CFP.
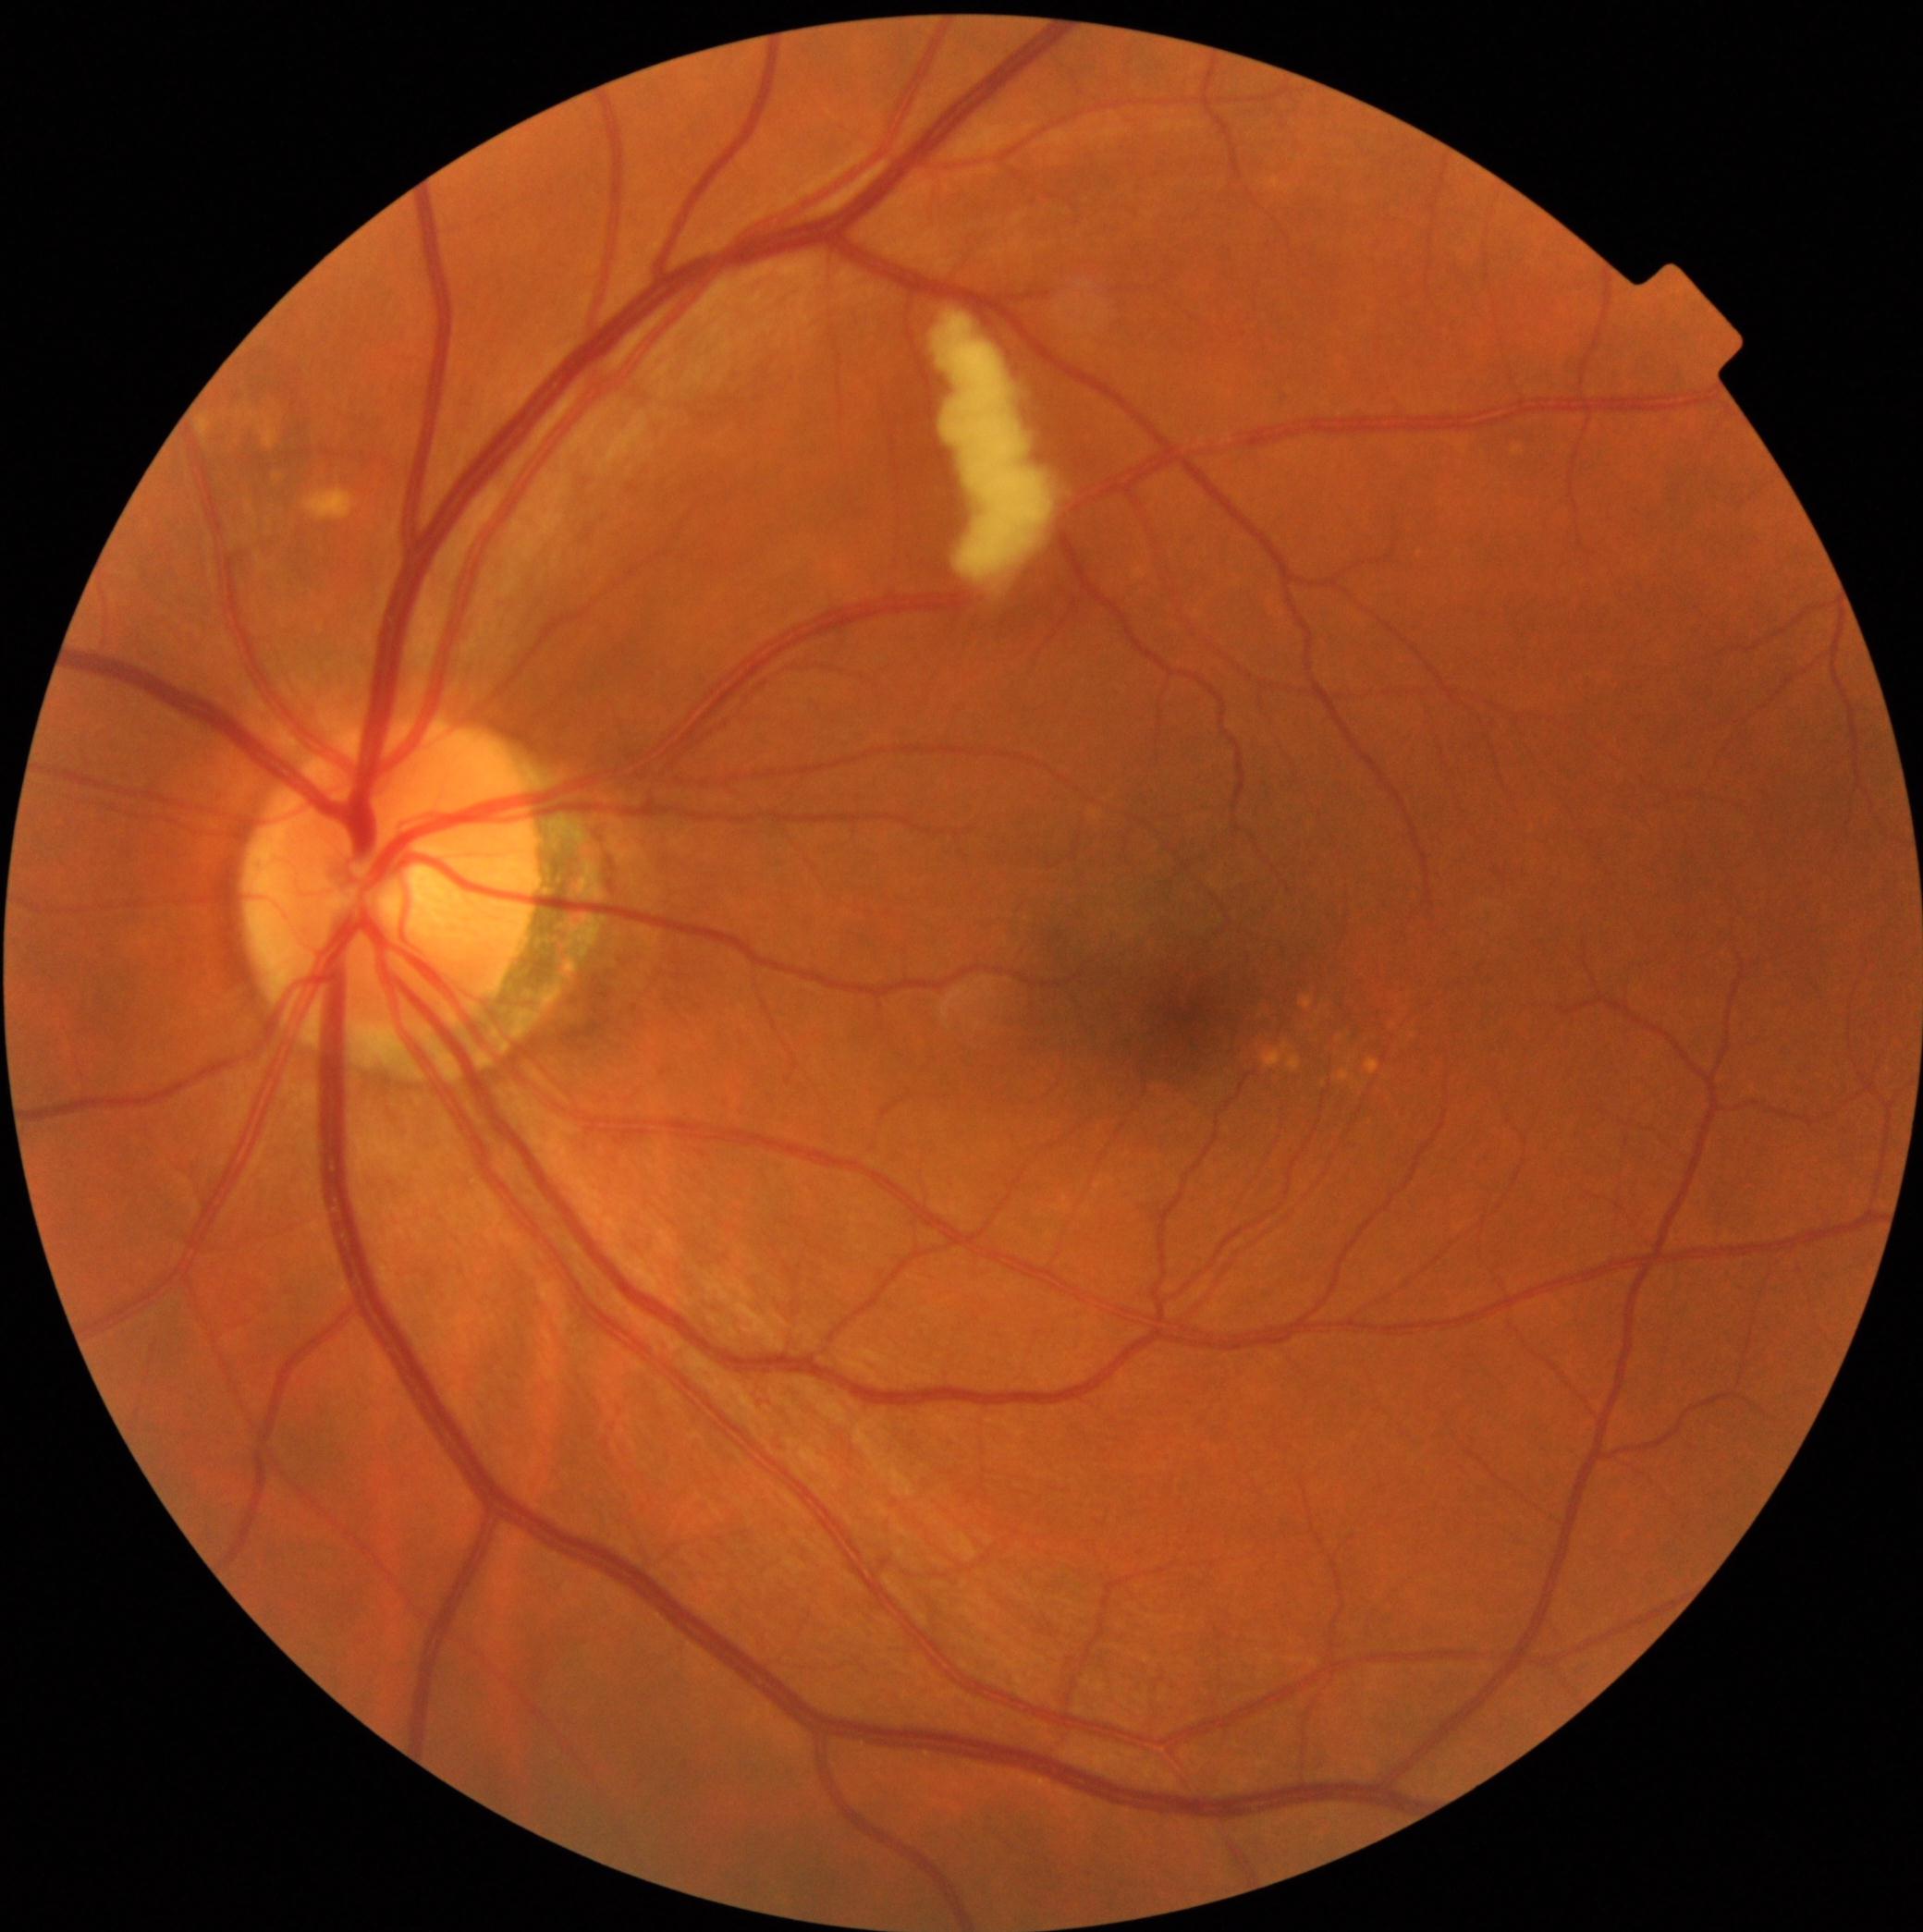

DR severity: grade 2. No EXs identified. SEs found at left=935, top=312, right=1054, bottom=585. No HEs identified. No MAs identified.